45-degree field of view · 2352 x 1568 pixels
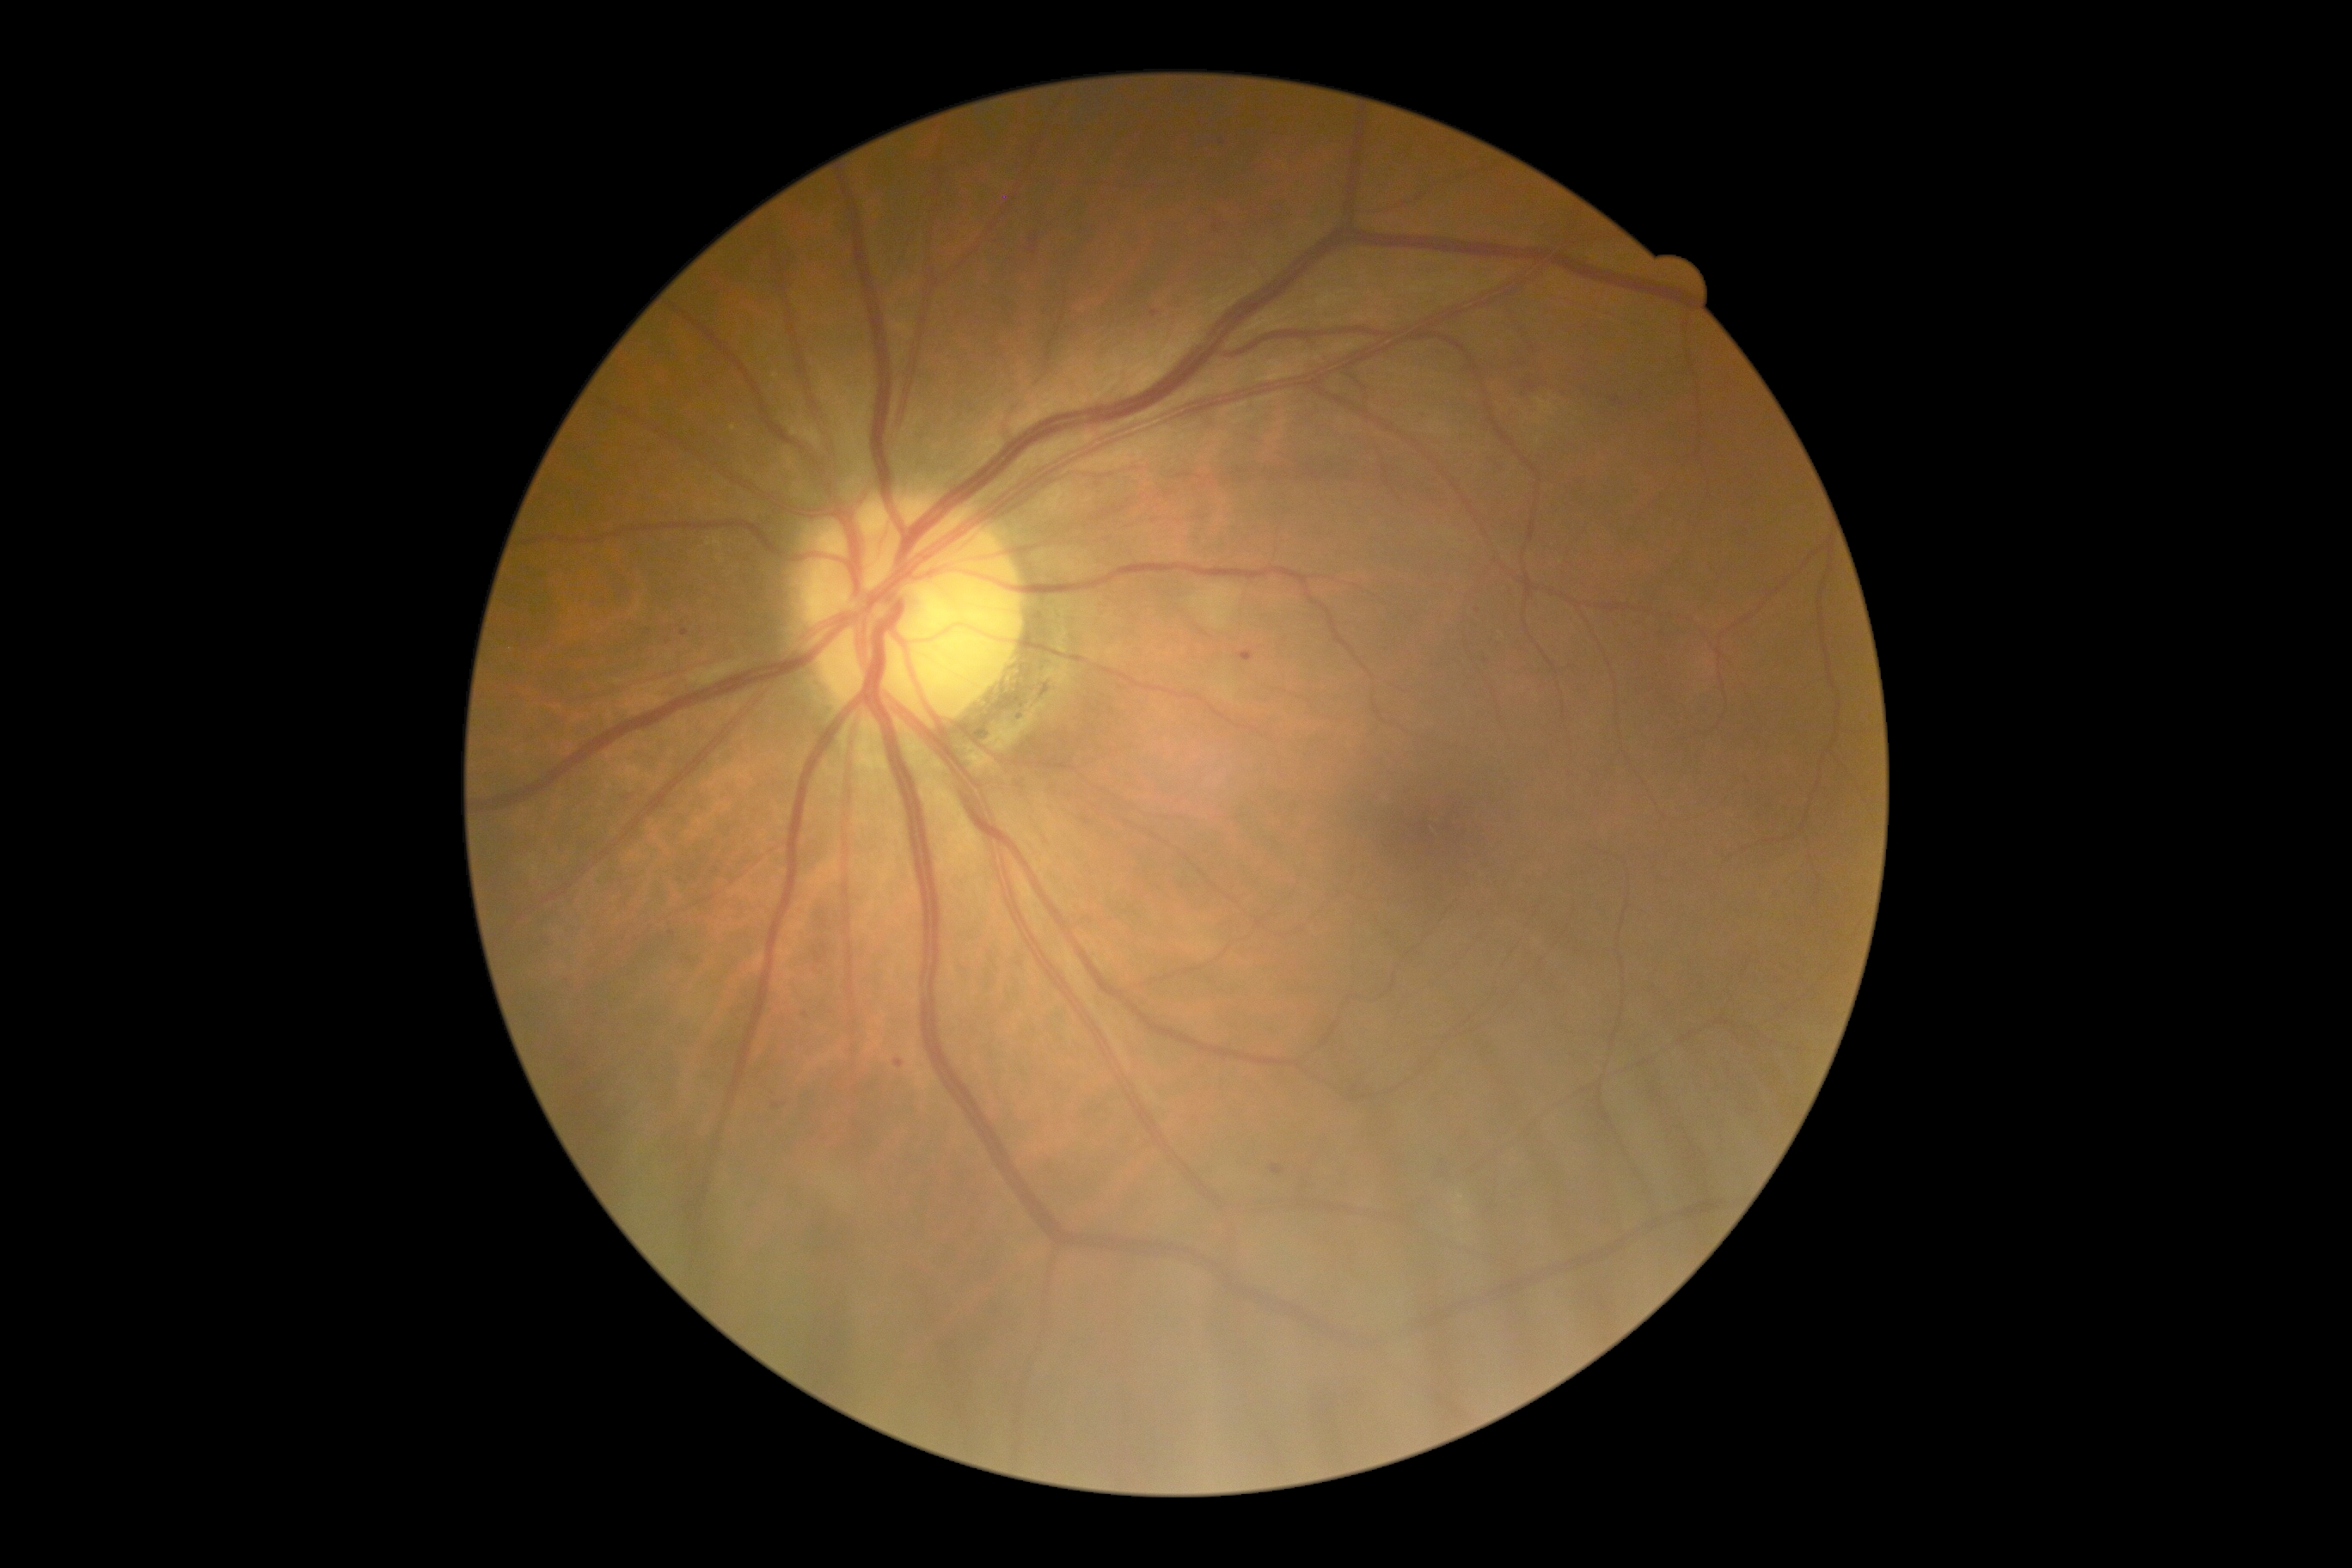
DR: moderate NPDR (grade 2).